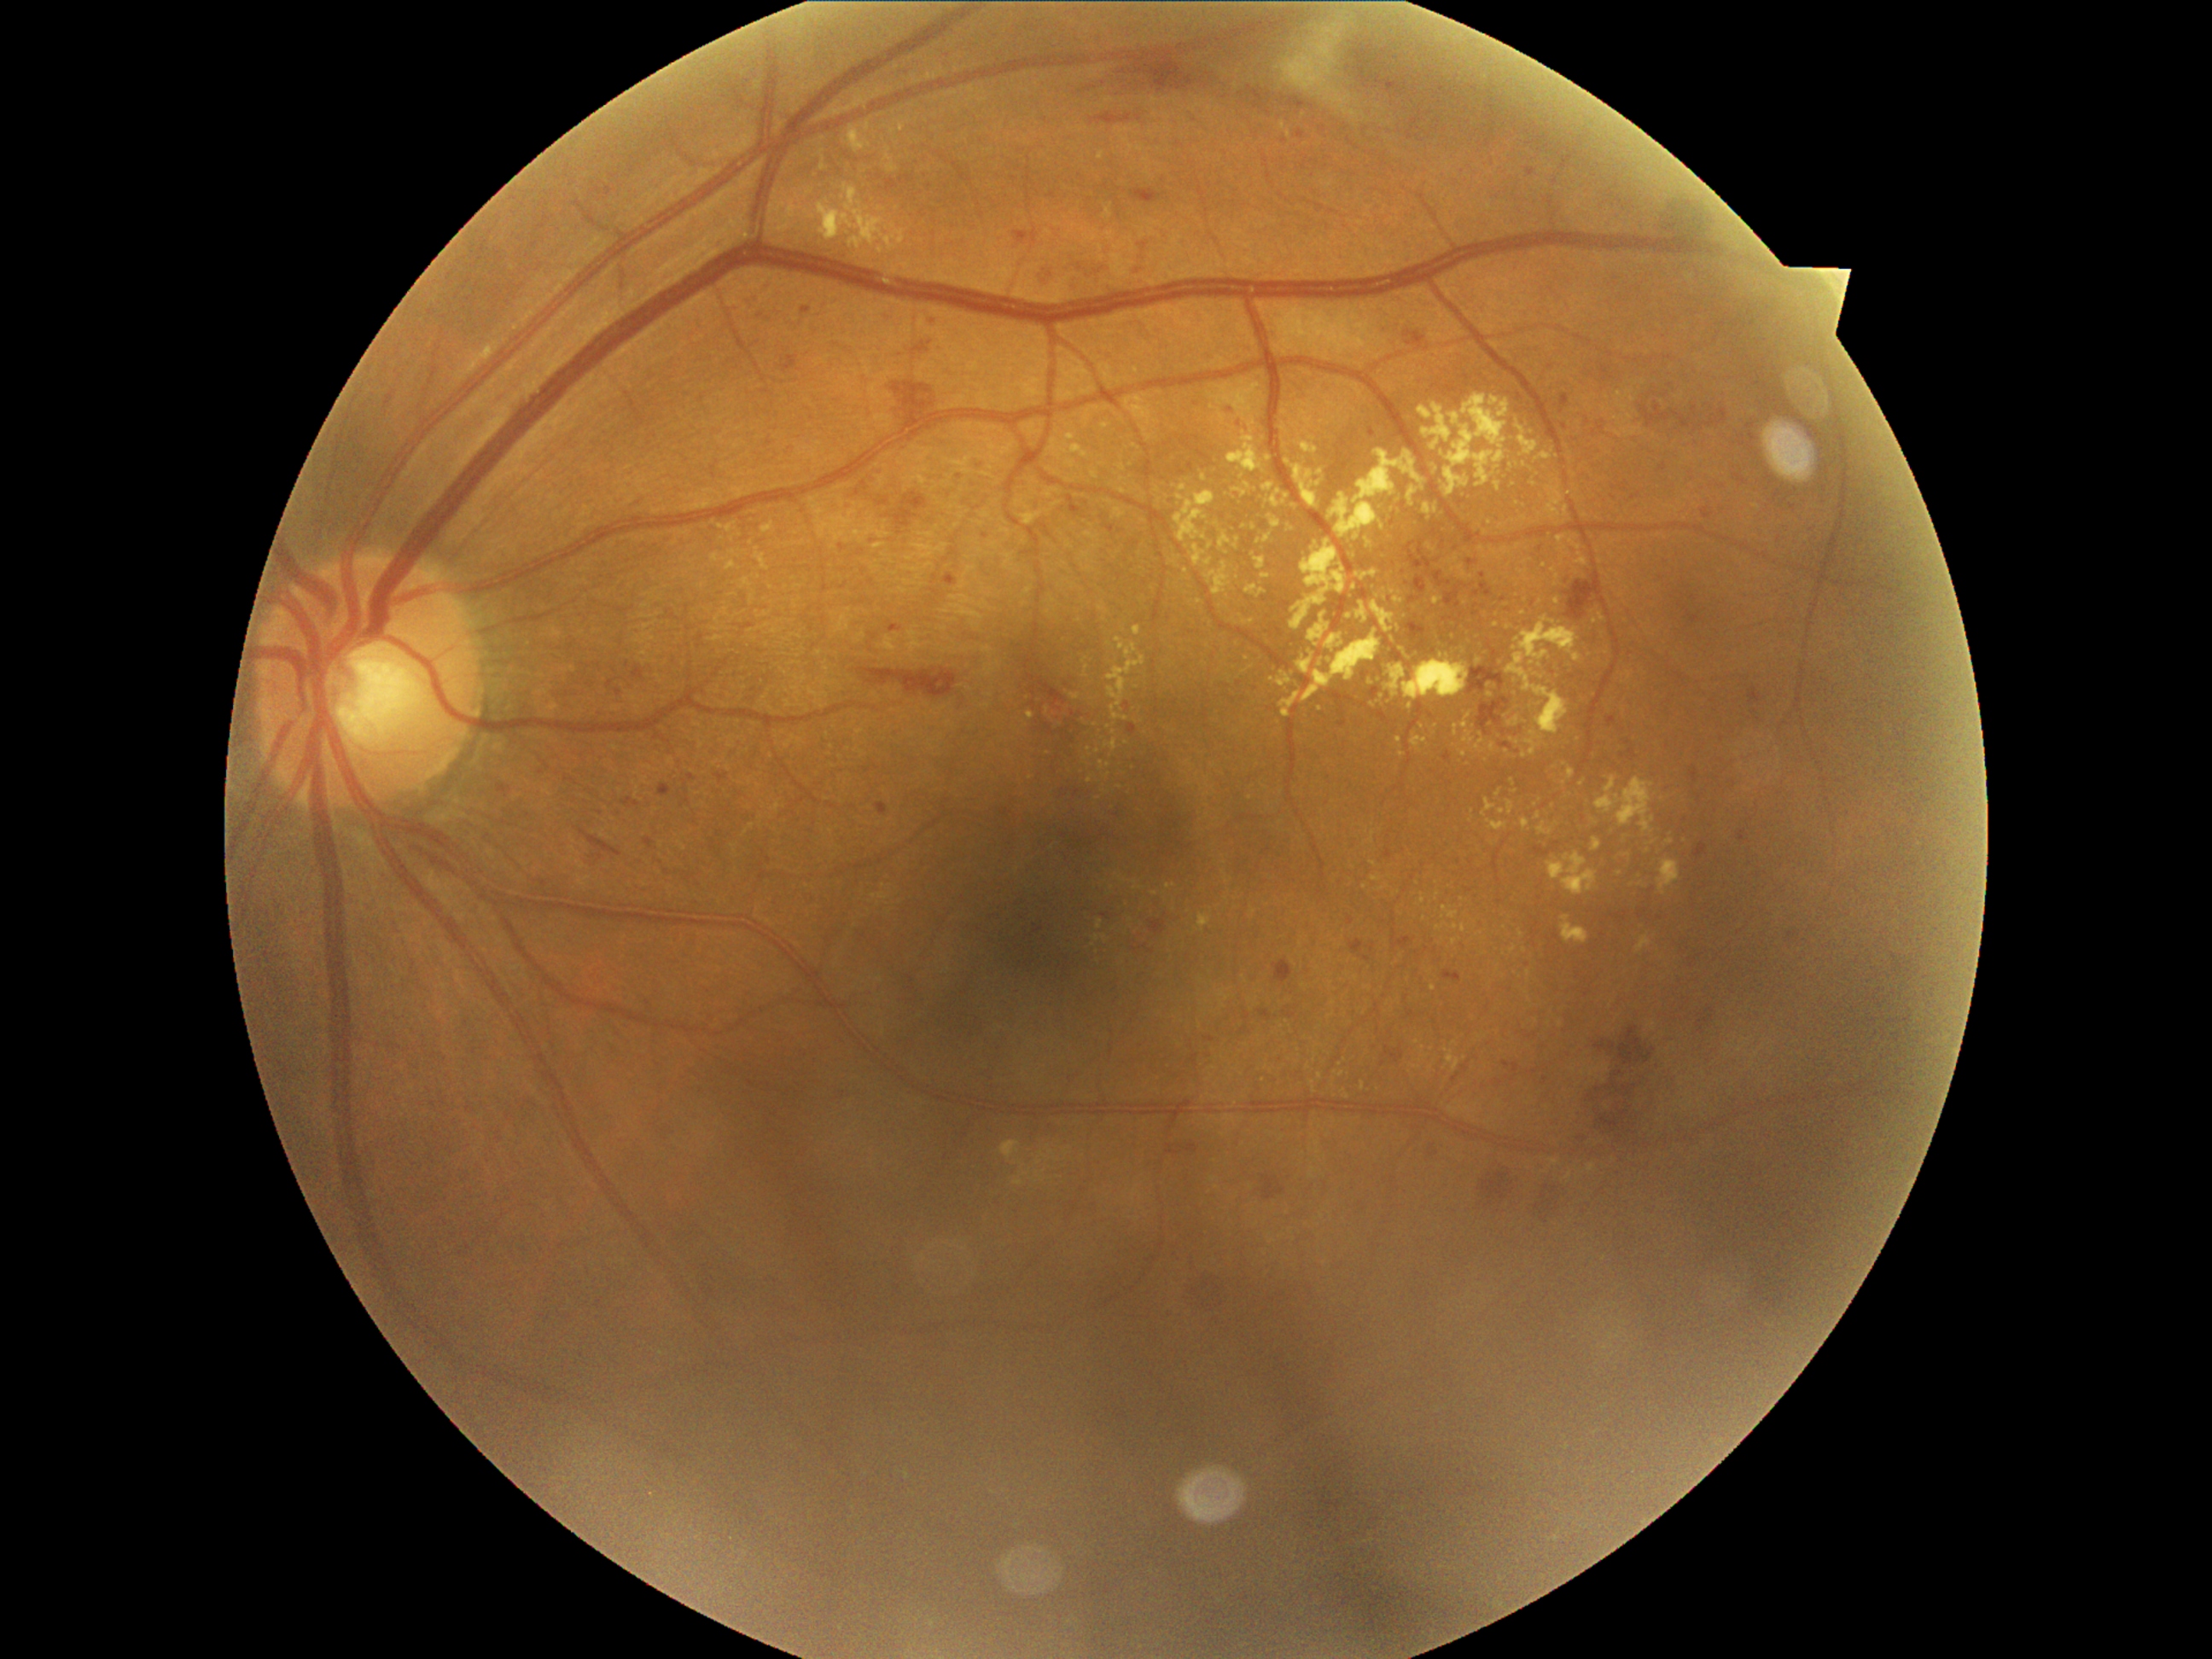

Retinopathy: moderate non-proliferative diabetic retinopathy (grade 2) — more than just microaneurysms but less than severe NPDR
A subset of detected lesions:
• microaneurysms (continued): x1=945, y1=574, x2=958, y2=588 | x1=646, y1=837, x2=663, y2=851 | x1=1701, y1=508, x2=1713, y2=520 | x1=1445, y1=752, x2=1452, y2=764 | x1=660, y1=783, x2=678, y2=791 | x1=1383, y1=849, x2=1394, y2=859 | x1=619, y1=801, x2=643, y2=813 | x1=1385, y1=86, x2=1392, y2=96 | x1=1629, y1=748, x2=1638, y2=760 | x1=839, y1=542, x2=846, y2=550 | x1=1370, y1=429, x2=1377, y2=438 | x1=952, y1=475, x2=963, y2=486 | x1=1349, y1=941, x2=1371, y2=963 | x1=1619, y1=482, x2=1631, y2=492
• Additional small microaneurysms near {"x": 1052, "y": 195} | {"x": 1285, "y": 142} | {"x": 986, "y": 535} | {"x": 1565, "y": 427}
• soft exudates: x1=1278, y1=16, x2=1358, y2=115
• hemorrhages (continued): x1=1431, y1=523, x2=1443, y2=537 | x1=1537, y1=1185, x2=1564, y2=1226 | x1=1414, y1=576, x2=1426, y2=595 | x1=1080, y1=52, x2=1225, y2=95 | x1=1383, y1=1045, x2=1404, y2=1064 | x1=1404, y1=330, x2=1426, y2=351 | x1=1069, y1=276, x2=1080, y2=294 | x1=631, y1=663, x2=658, y2=687 | x1=1255, y1=1175, x2=1288, y2=1201 | x1=1474, y1=583, x2=1494, y2=598 | x1=579, y1=827, x2=624, y2=856 | x1=847, y1=460, x2=885, y2=504 | x1=856, y1=668, x2=887, y2=684 | x1=1692, y1=405, x2=1697, y2=416 | x1=902, y1=341, x2=941, y2=359 | x1=1090, y1=114, x2=1132, y2=125 | x1=1194, y1=1266, x2=1235, y2=1318 | x1=1131, y1=540, x2=1141, y2=547 | x1=1597, y1=1042, x2=1617, y2=1052
• Additional small hemorrhages near {"x": 1483, "y": 575}
• hard exudates (continued): x1=1769, y1=774, x2=1776, y2=784 | x1=755, y1=552, x2=767, y2=569 | x1=1204, y1=561, x2=1231, y2=597 | x1=1117, y1=875, x2=1127, y2=883 | x1=1423, y1=504, x2=1440, y2=520 | x1=1097, y1=919, x2=1102, y2=929 | x1=1506, y1=615, x2=1581, y2=735 | x1=1445, y1=1047, x2=1462, y2=1073 | x1=820, y1=163, x2=829, y2=172 | x1=1289, y1=504, x2=1303, y2=513
• Additional small hard exudates near {"x": 1490, "y": 523} | {"x": 1456, "y": 942} | {"x": 1121, "y": 788} | {"x": 1432, "y": 1068} | {"x": 1595, "y": 822} | {"x": 822, "y": 154} | {"x": 1316, "y": 545} | {"x": 1622, "y": 596} | {"x": 1047, "y": 711} | {"x": 1321, "y": 709}